Color fundus photograph; 45-degree field of view:
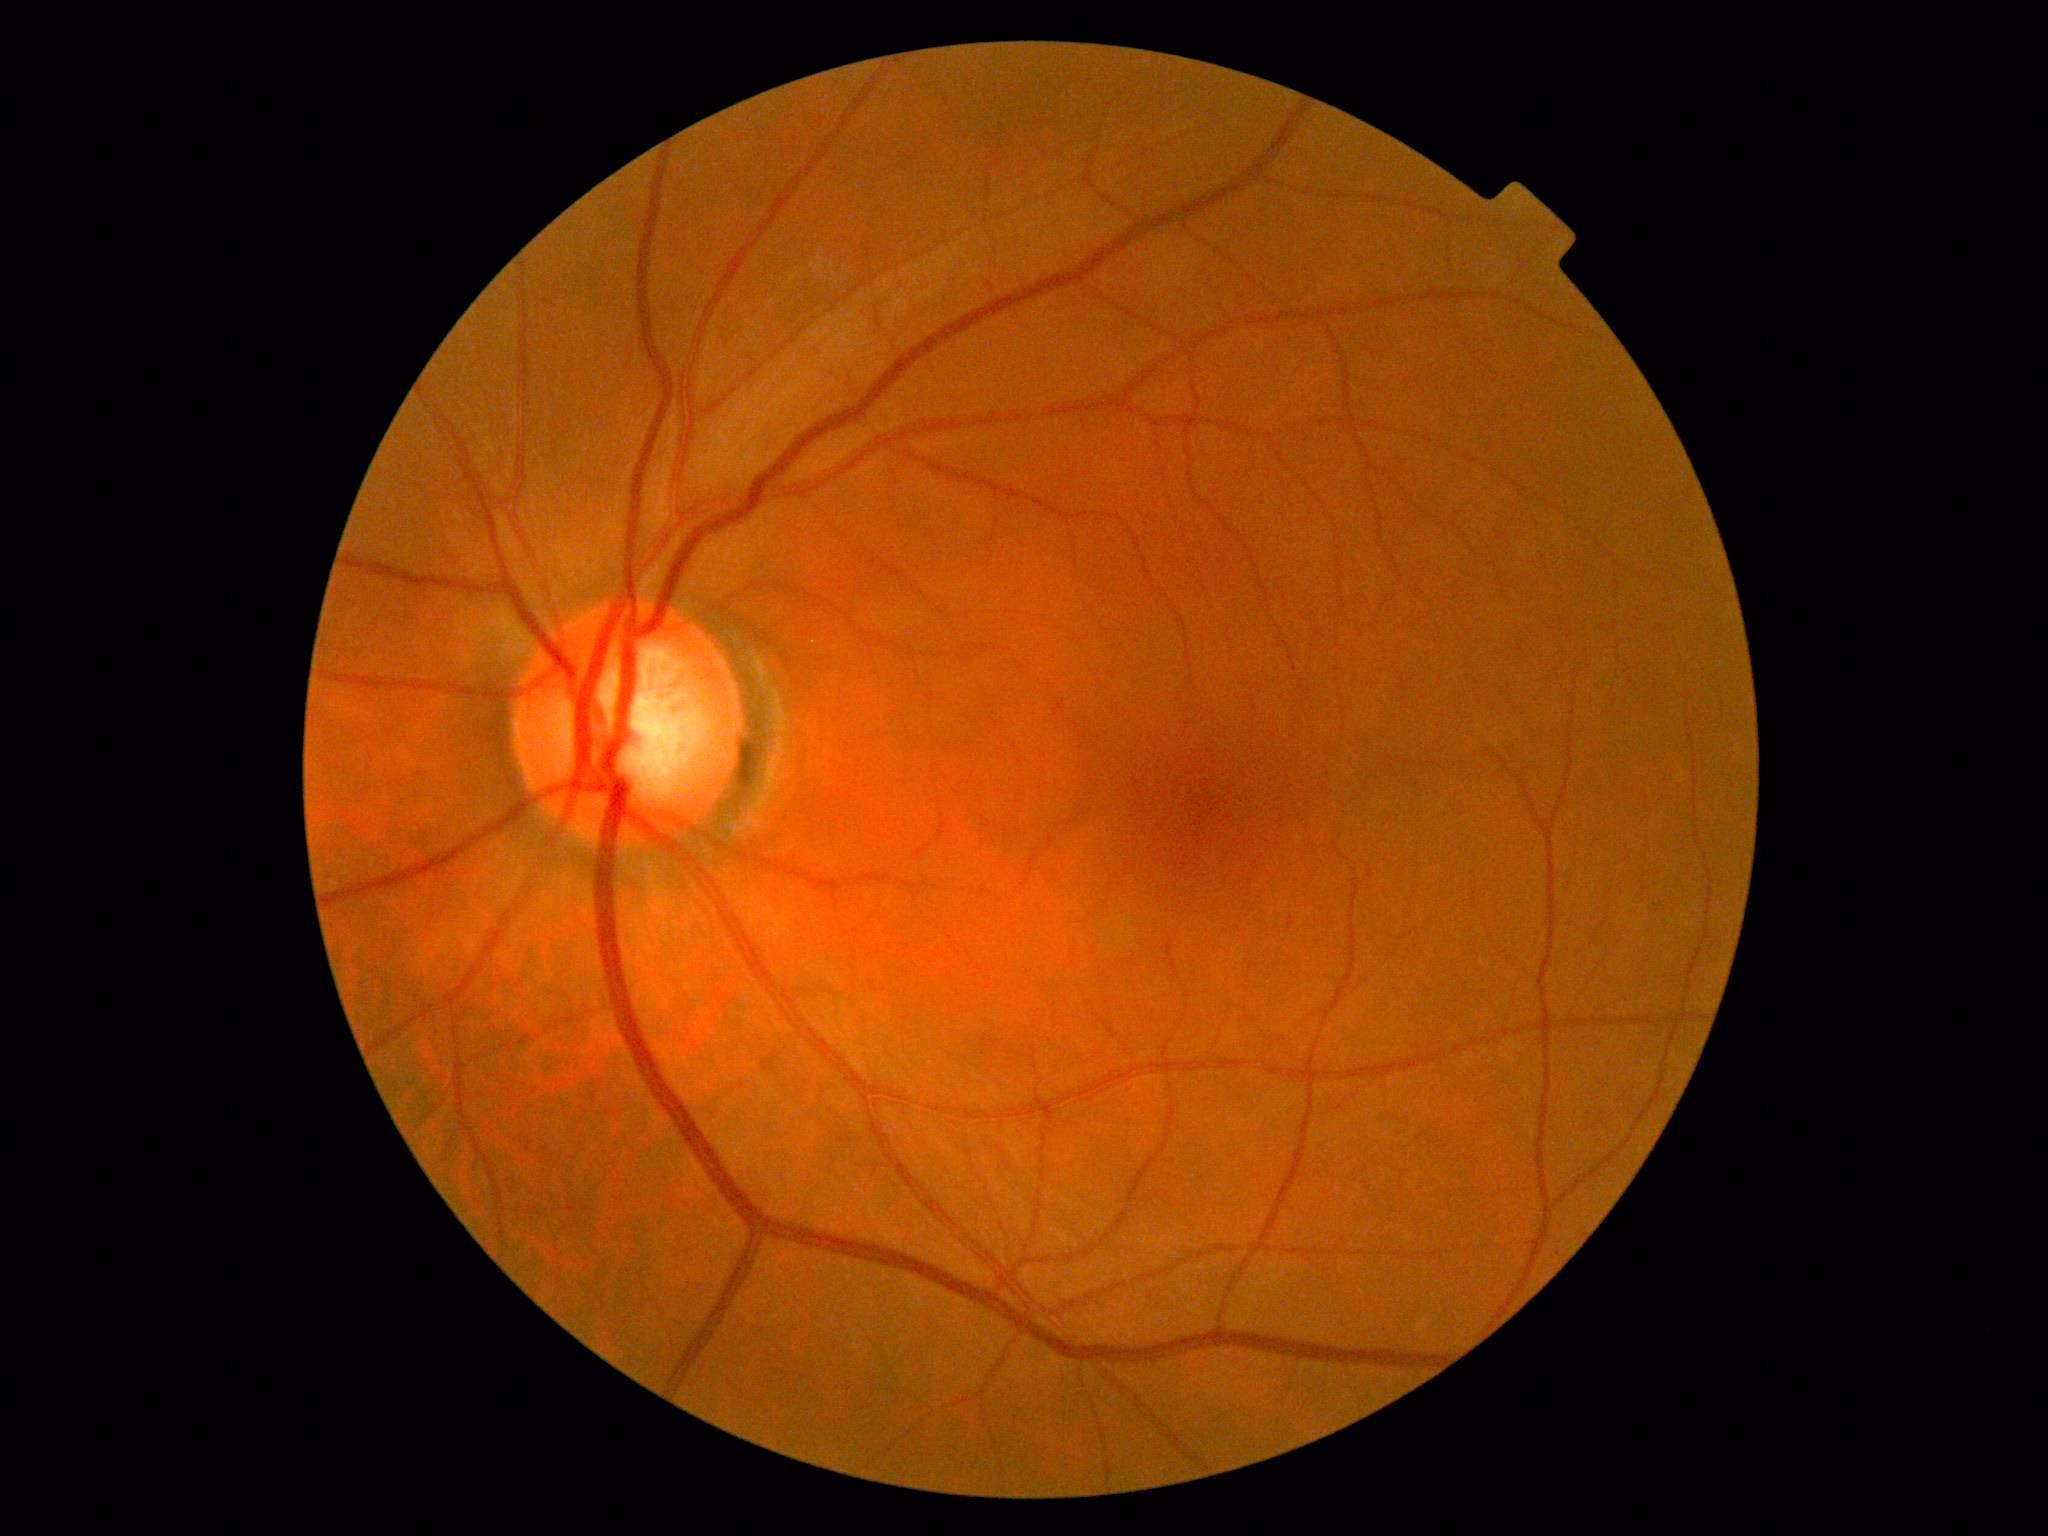
Diabetic retinopathy (DR): no apparent retinopathy (grade 0).